Retinal fundus photograph · FOV: 45 degrees:
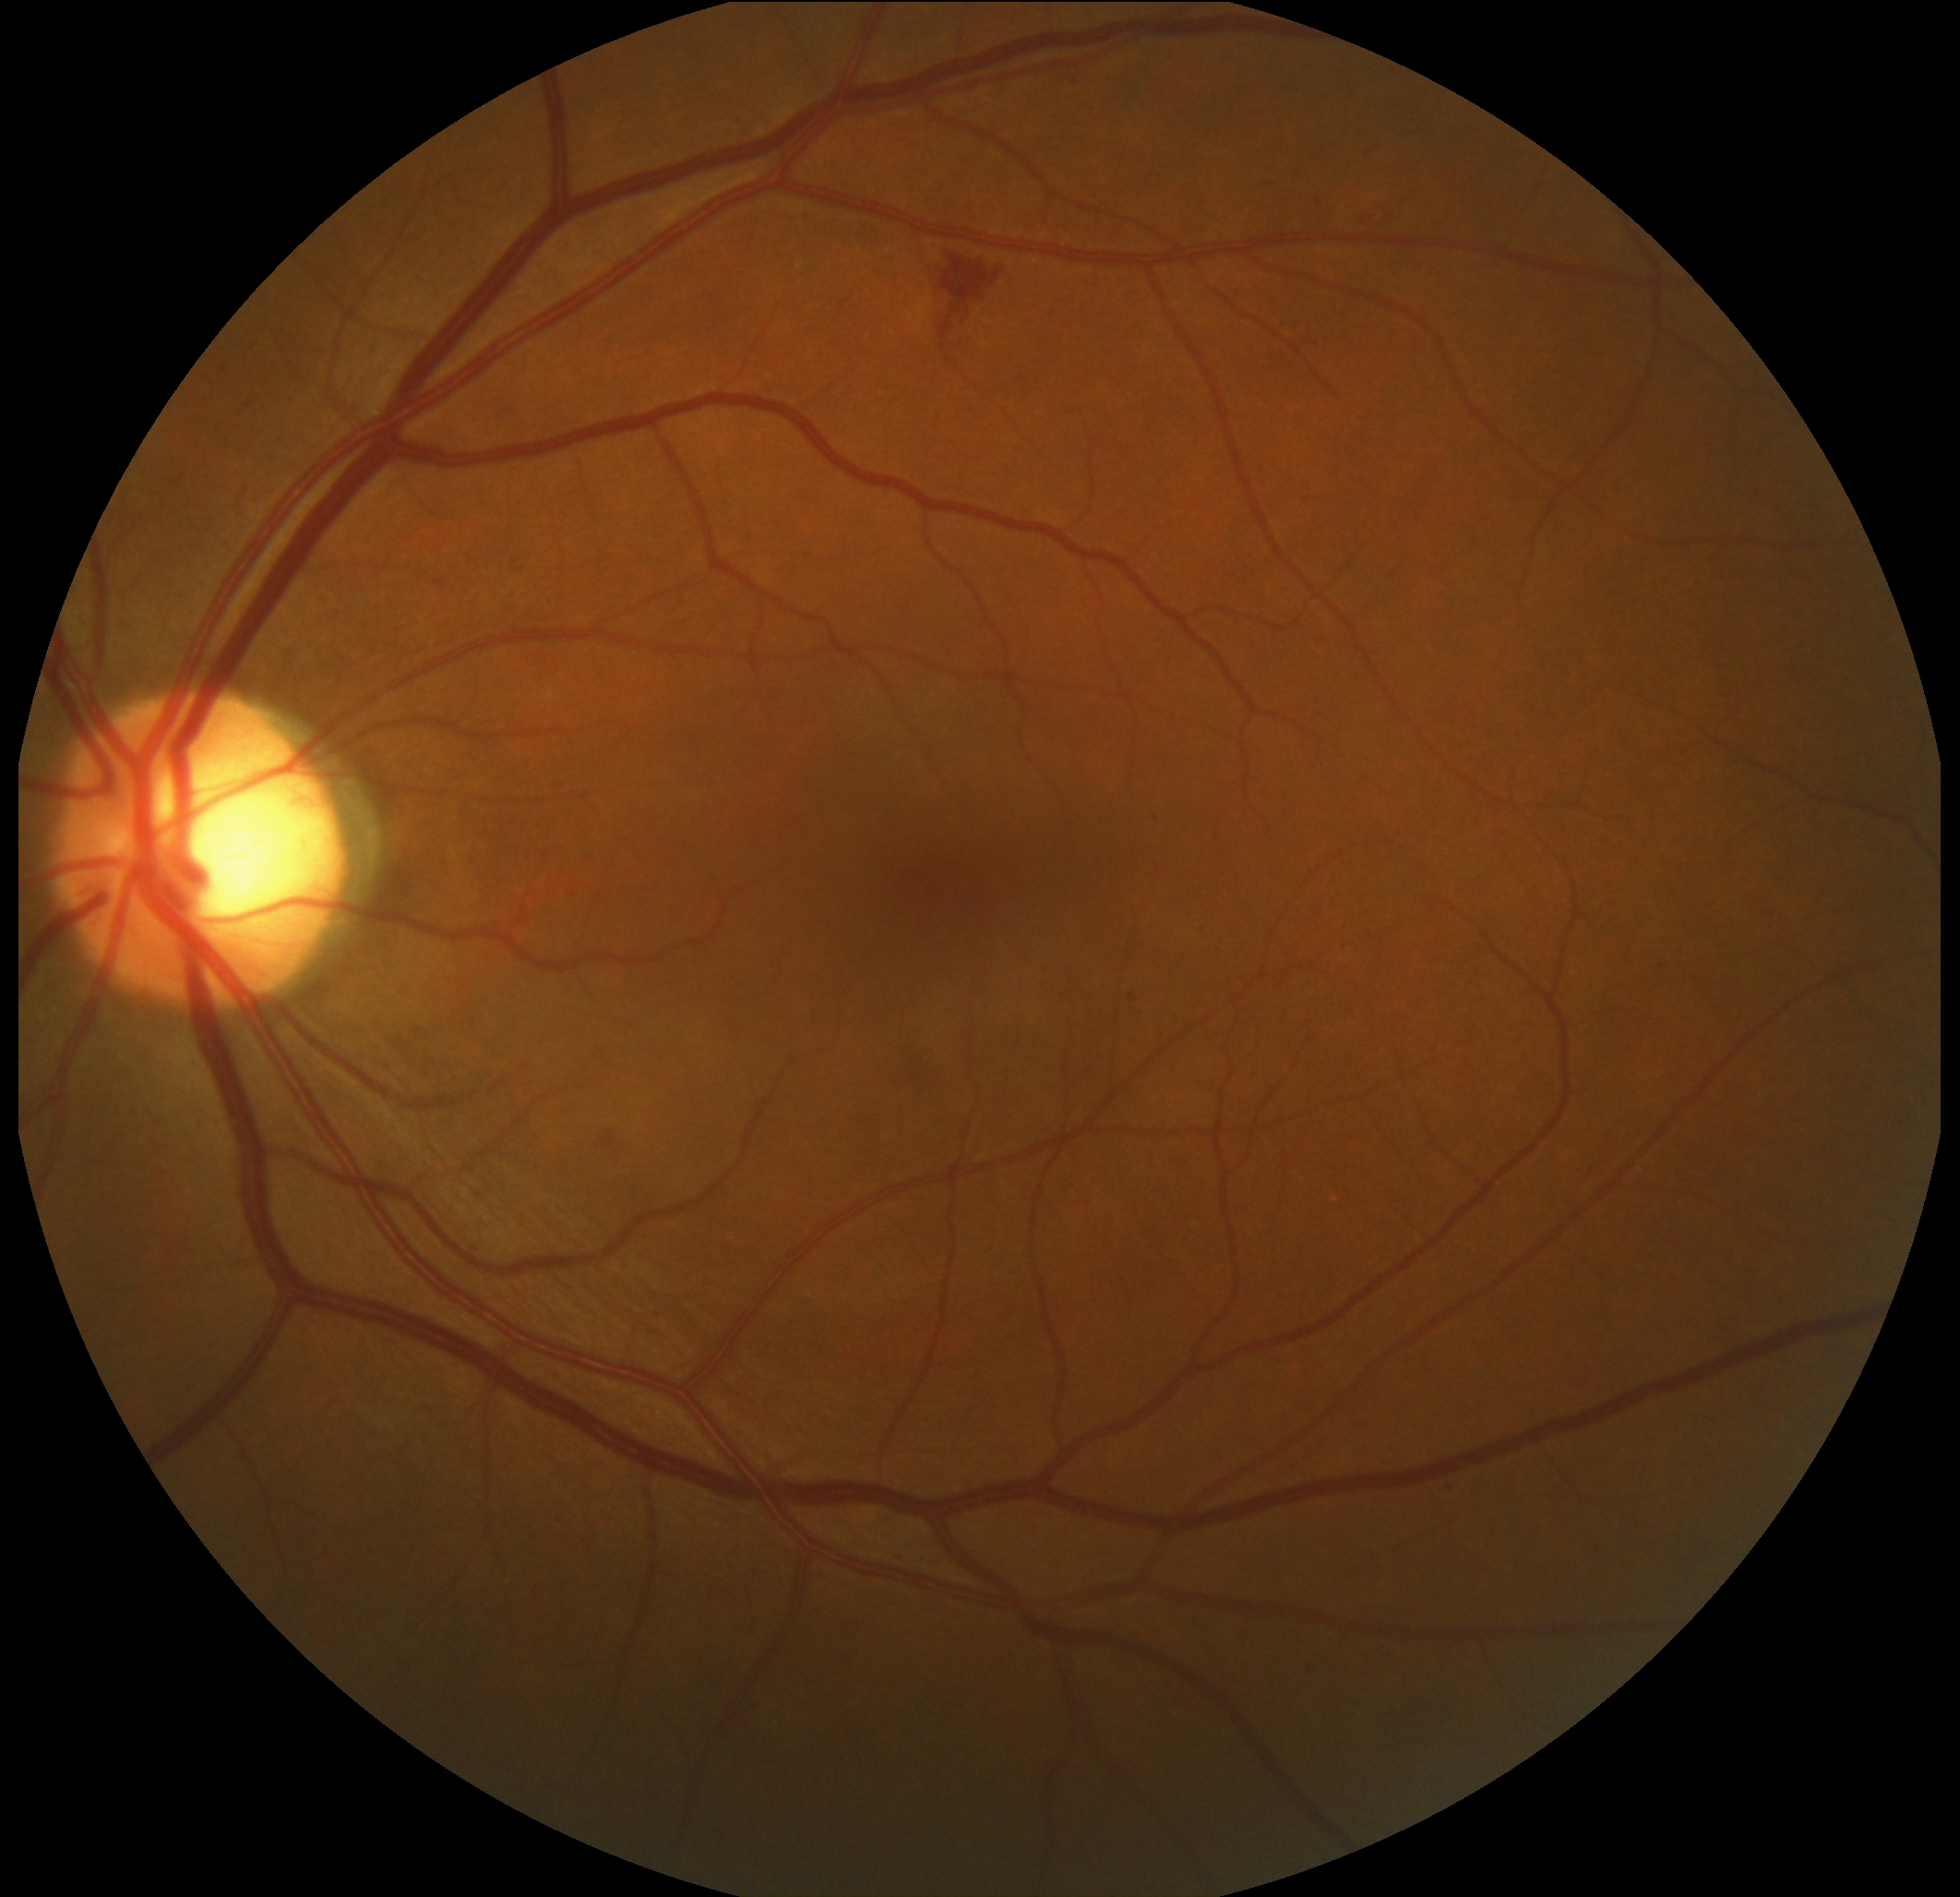

  dr_grade: moderate non-proliferative diabetic retinopathy (grade 2)
  dr_category: non-proliferative diabetic retinopathy